Color fundus photograph, 50-degree field of view: 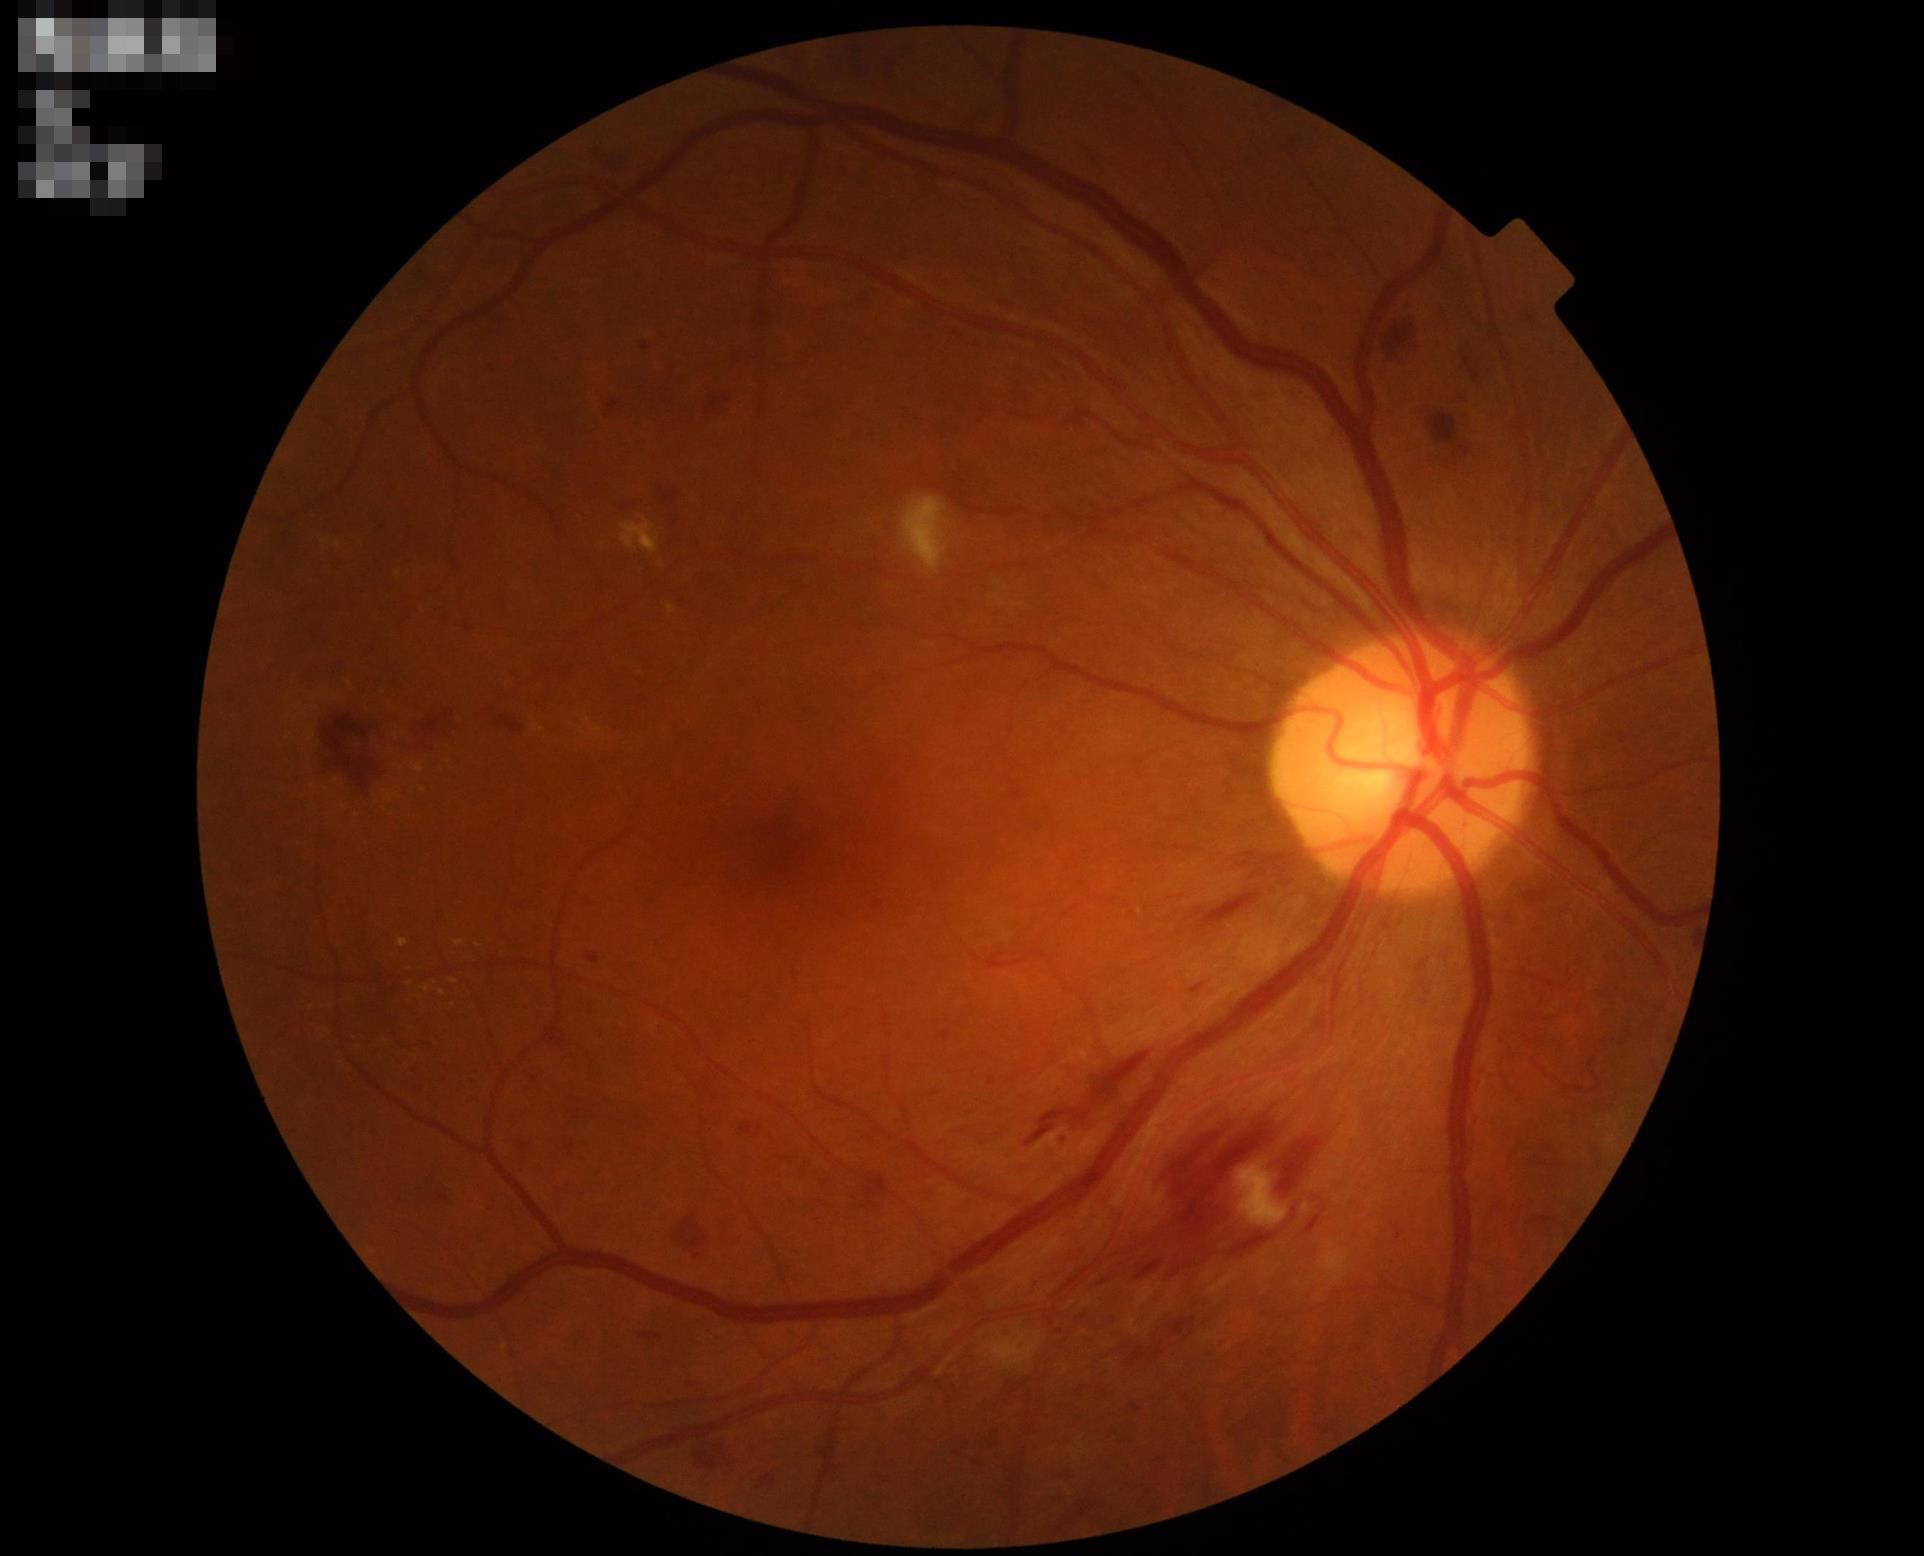

Acceptable image quality.
Even illumination with no color cast.
Vessels and details are readily distinguishable.